FOV: 45 degrees. Image size 848x848. Davis DR grading. NIDEK AFC-230 fundus camera:
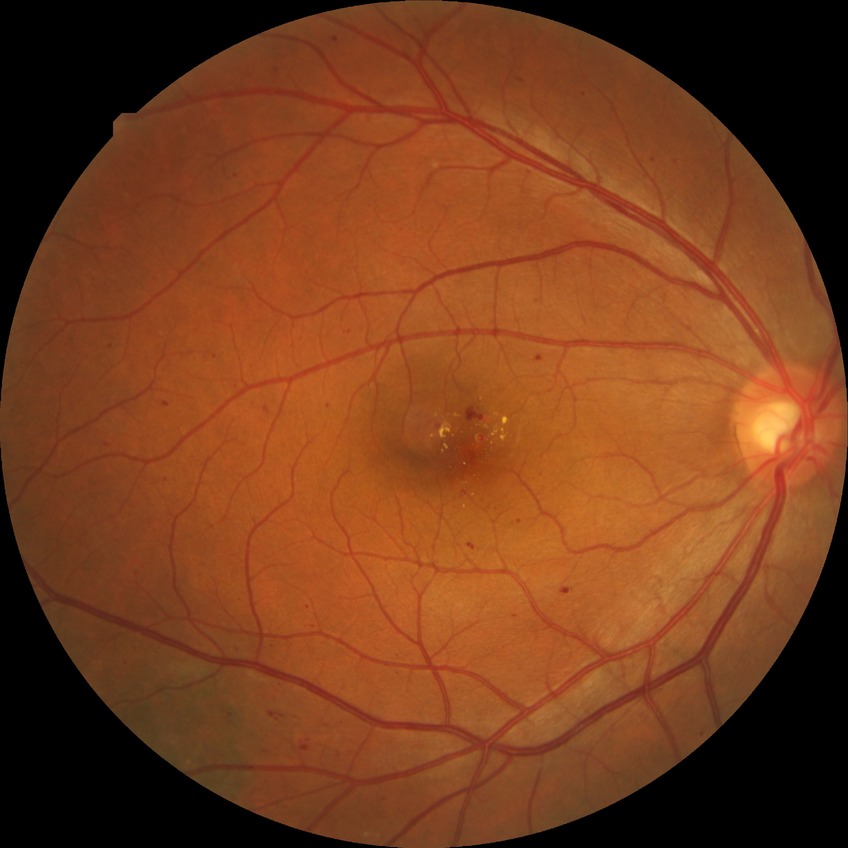

Diabetic retinopathy (DR) is simple diabetic retinopathy (SDR).